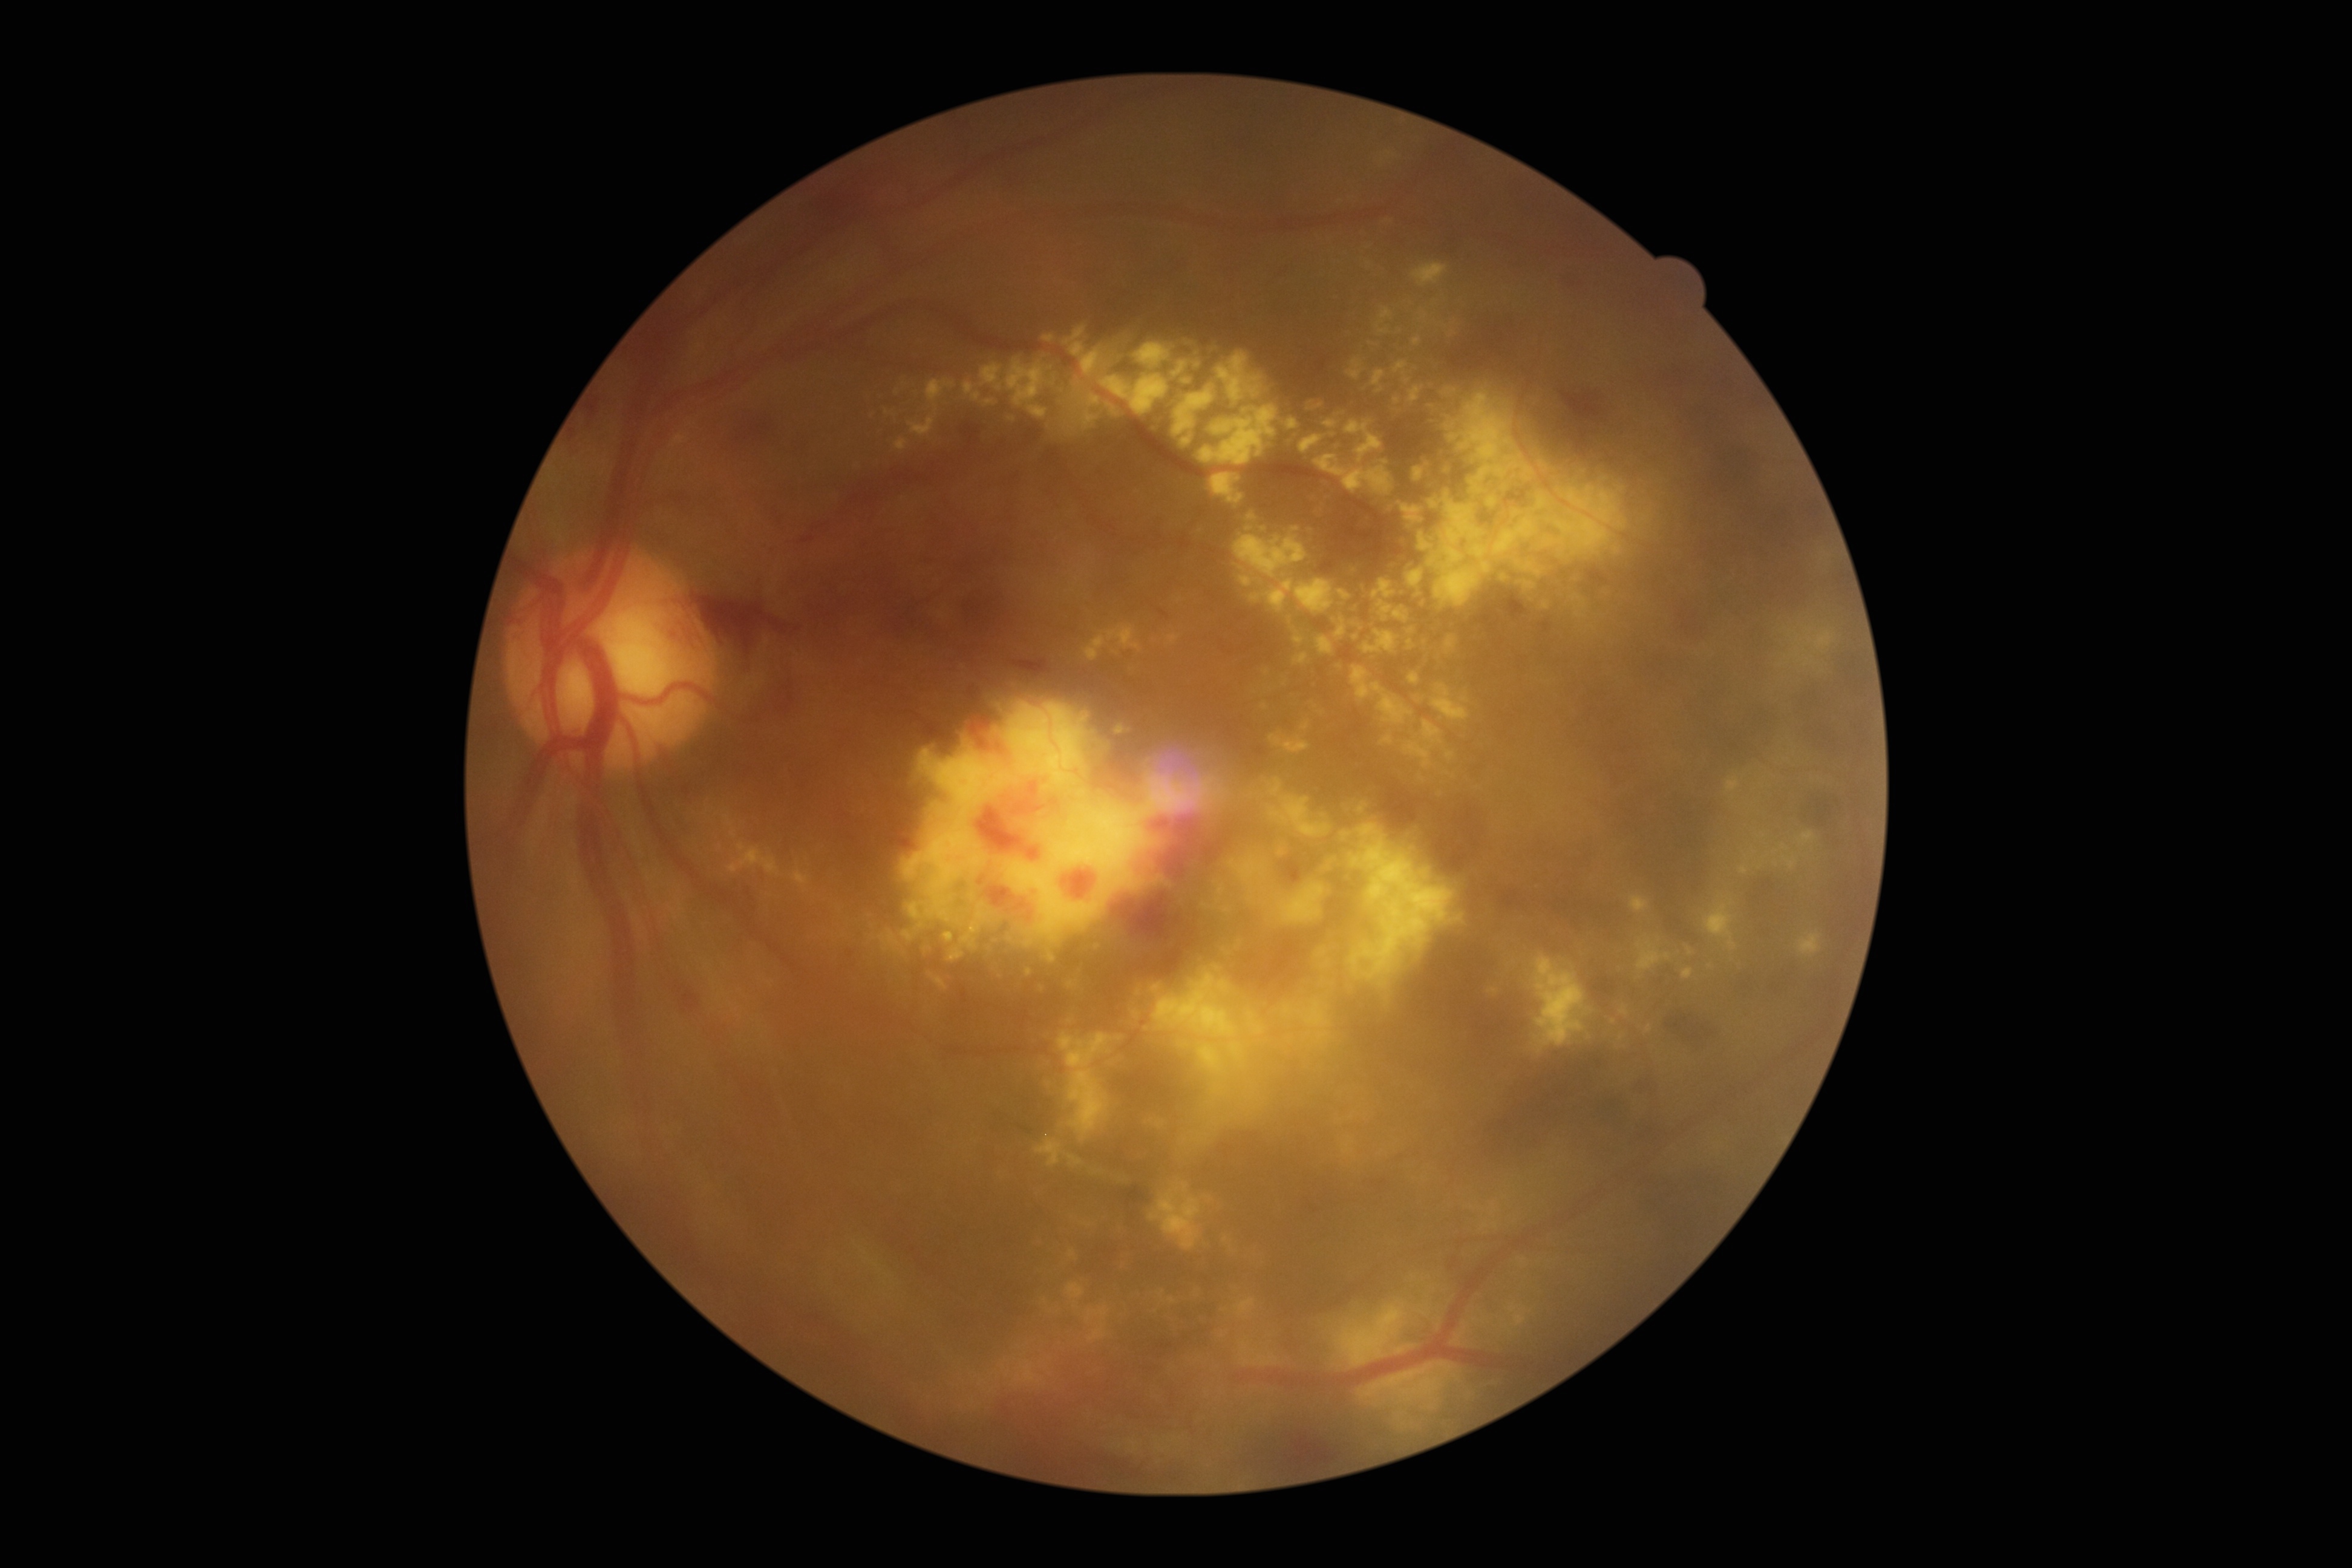

Diabetic retinopathy (DR): grade 4.